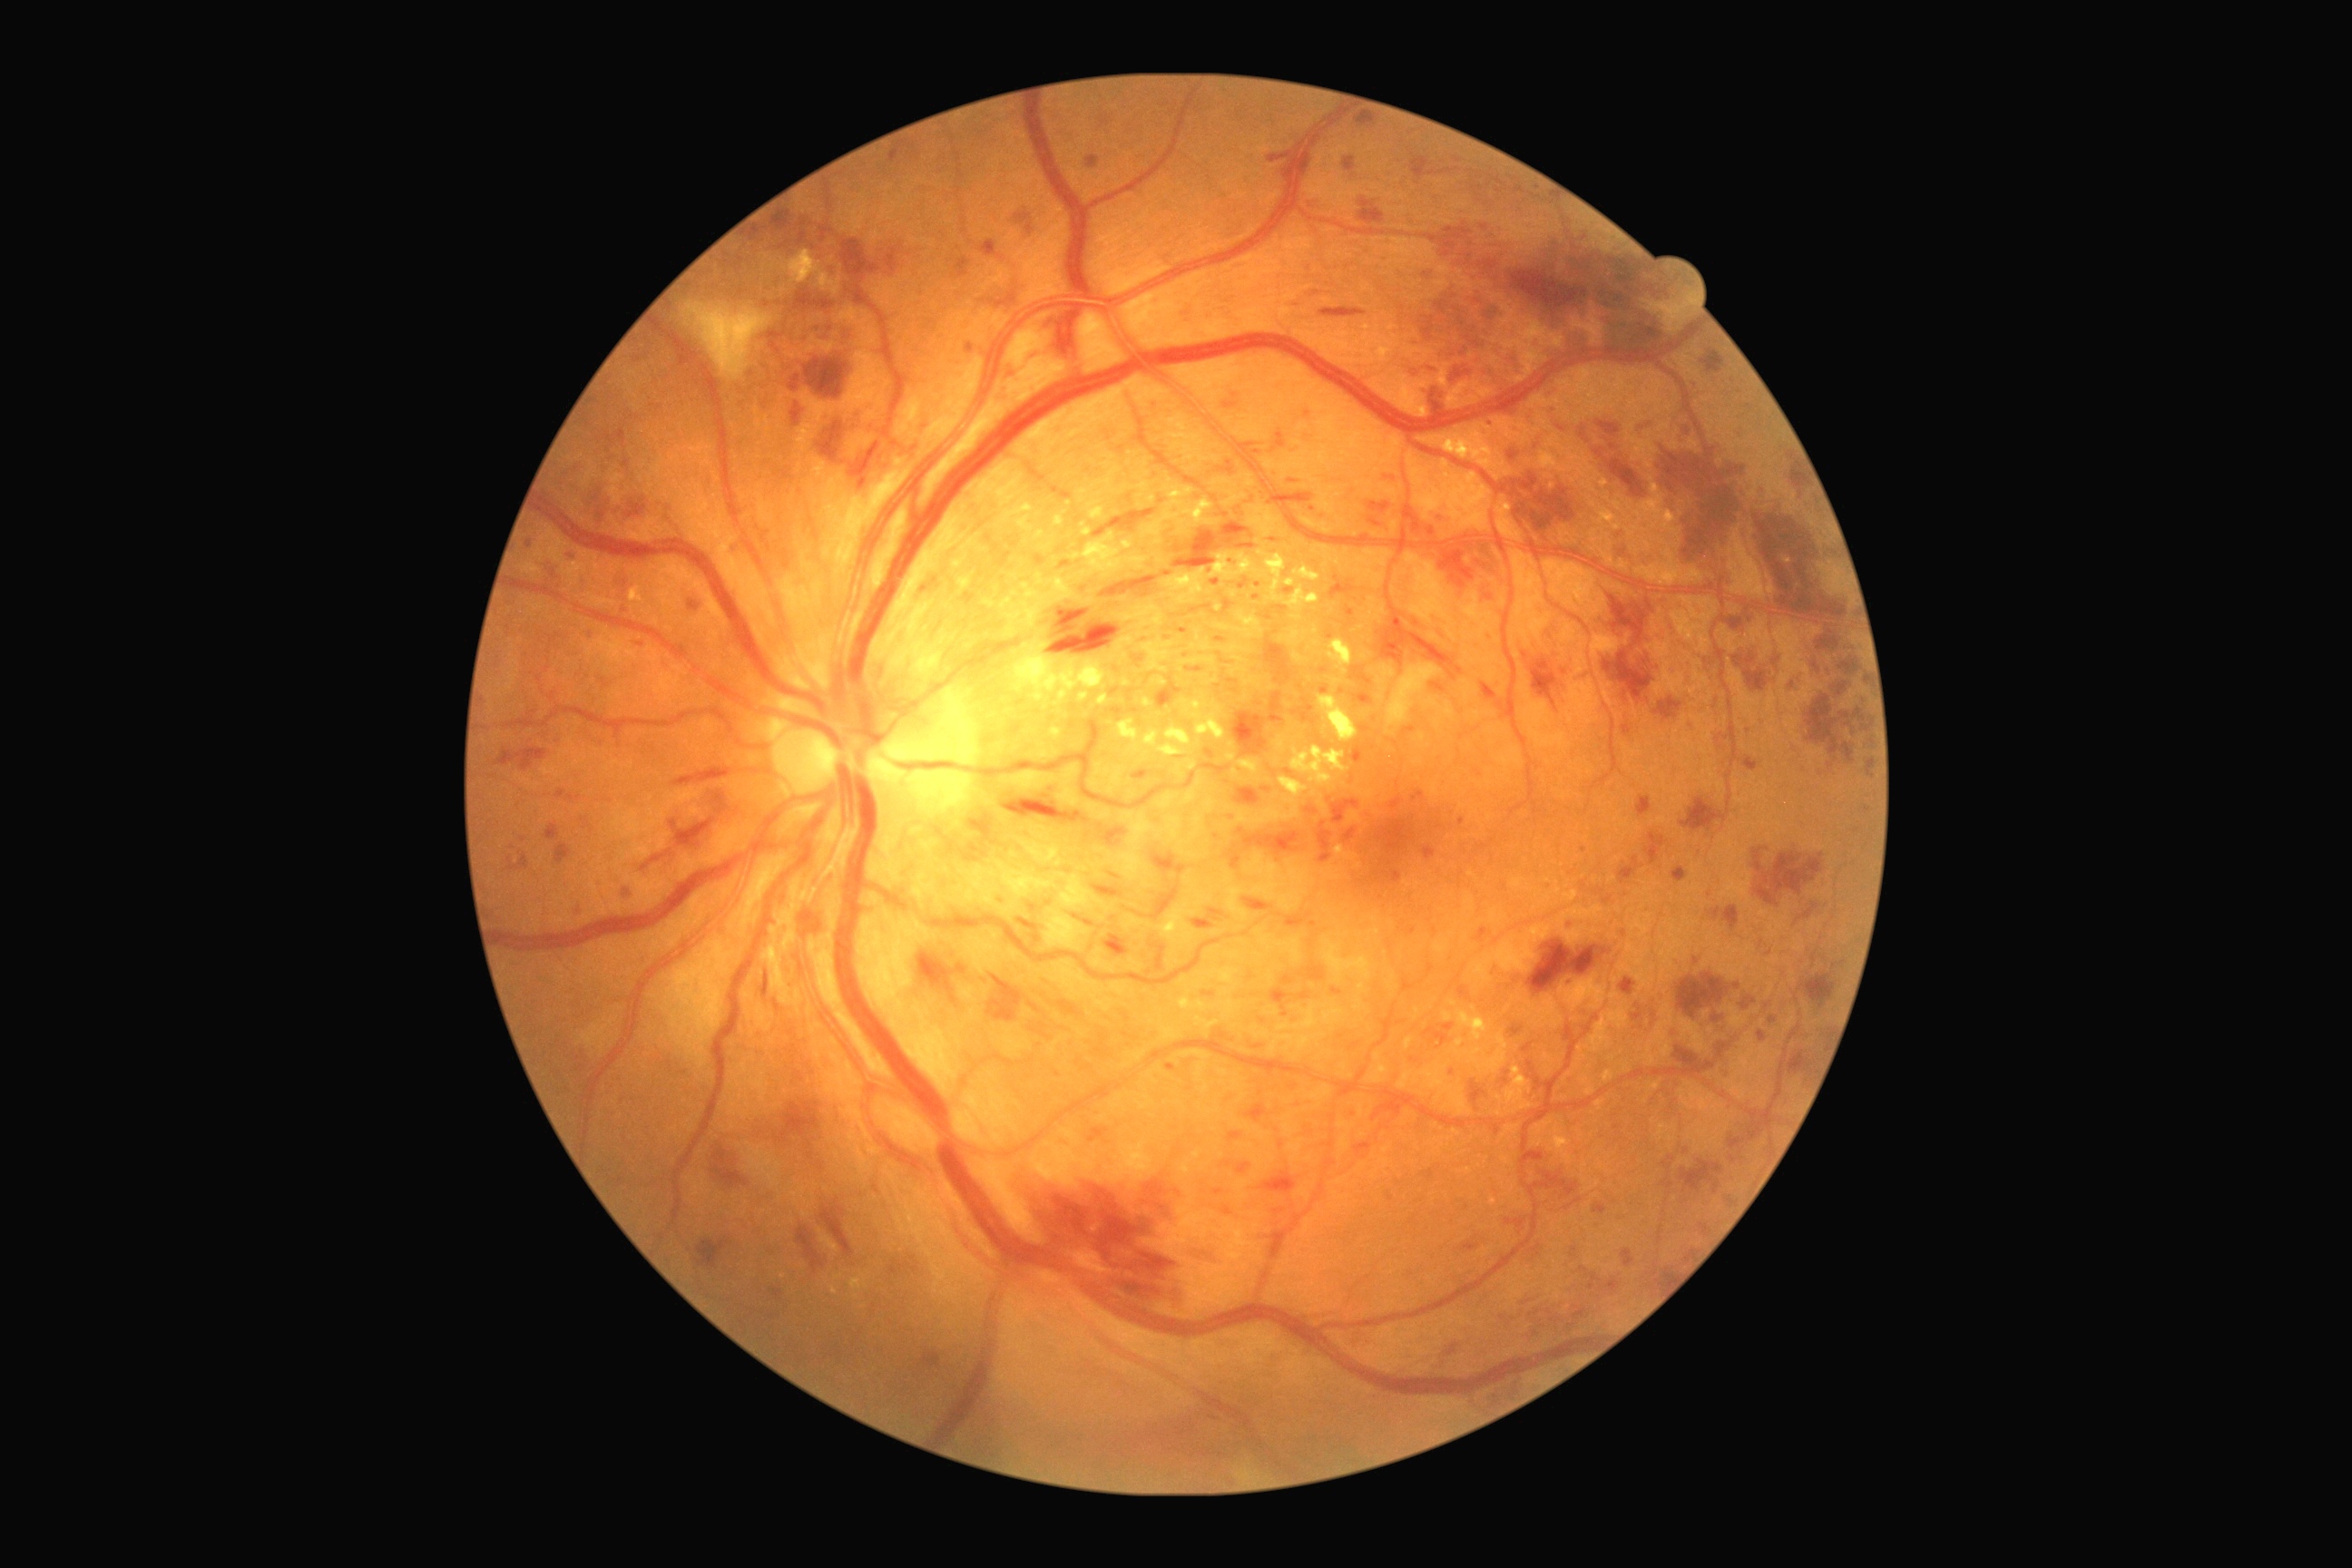 Diabetic retinopathy grade is 3 (severe NPDR).
Hard exudates include lesions at (1159,698,1226,758), (1179,992,1217,1012), (1313,640,1322,647), (1083,529,1092,538), (1079,692,1090,703), (1465,1032,1509,1073), (1585,1088,1596,1095), (1050,729,1063,741), (1280,631,1306,649), (1001,573,1095,638), (1144,730,1161,747), (1444,1012,1453,1023), (1231,667,1277,694).
Small hard exudates near Point(1453, 1003), Point(1231, 745), Point(1494, 1202), Point(1289, 718).
Hemorrhages include lesions at (1754,848,1825,906), (1367,502,1391,514), (1153,888,1179,919), (1266,642,1291,683), (1531,662,1558,709), (1233,712,1268,758), (1618,858,1643,885), (1701,351,1725,375), (1478,585,1496,605), (1838,658,1863,676), (1003,794,1090,825), (1770,1139,1774,1148), (1812,663,1821,672), (1758,485,1769,498), (1798,903,1819,921), (1093,509,1155,538), (545,825,560,841), (1014,1164,1186,1304).
Small hemorrhages near Point(1821, 774).
Microaneurysms include lesions at (1277,431,1286,447), (1547,622,1562,645), (1596,449,1603,458), (1355,1142,1373,1157), (1384,476,1396,482), (1331,576,1355,600), (1086,155,1101,168), (1409,928,1415,936), (1004,368,1014,378), (1622,1250,1634,1268), (1110,872,1121,879), (1565,917,1571,926), (1622,725,1632,736), (1485,422,1493,429), (1714,1181,1721,1193).
Small microaneurysms near Point(736, 548), Point(1502, 1317), Point(1692, 726), Point(524, 840).